No pharmacologic dilation · graded on the modified Davis scale — 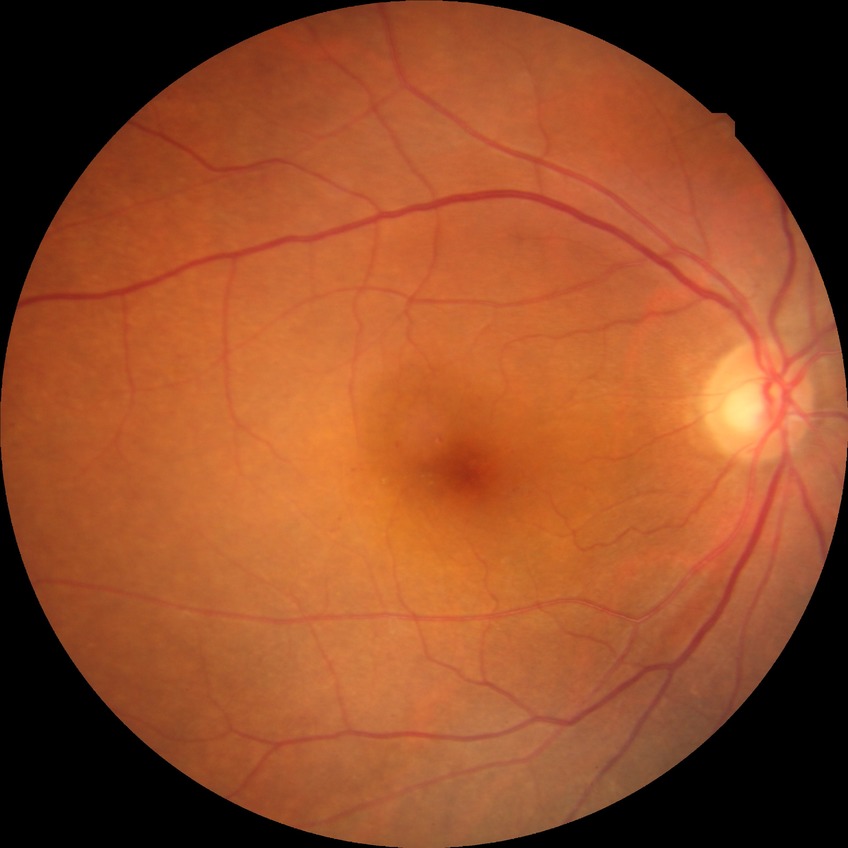
diabetic retinopathy severity = simple diabetic retinopathy.